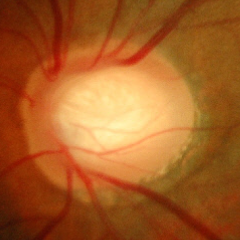
Fundus appearance consistent with no glaucomatous changes.